Diabetic retinopathy graded by the modified Davis classification:
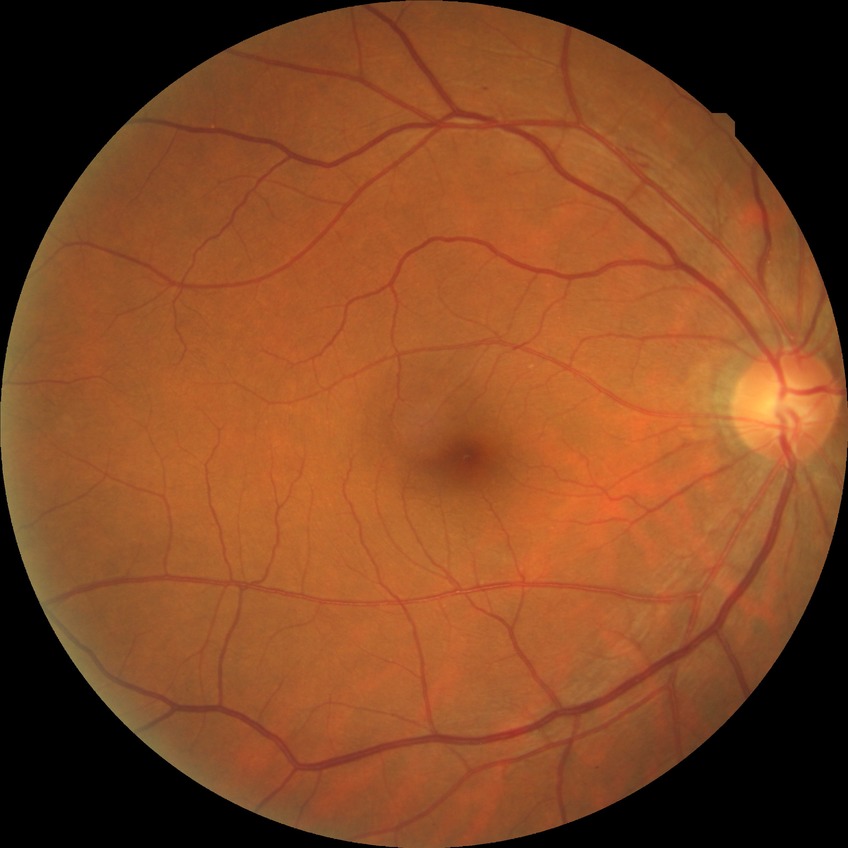
Retinopathy stage is simple diabetic retinopathy.